Modified Davis classification
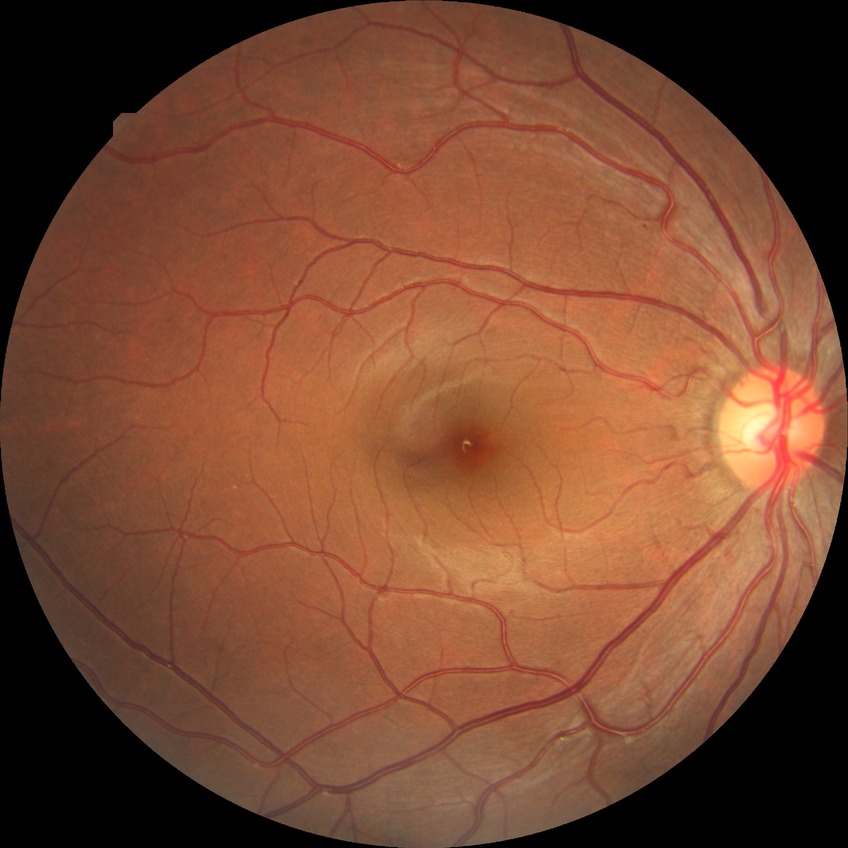 diabetic retinopathy (DR)=NDR (no diabetic retinopathy).